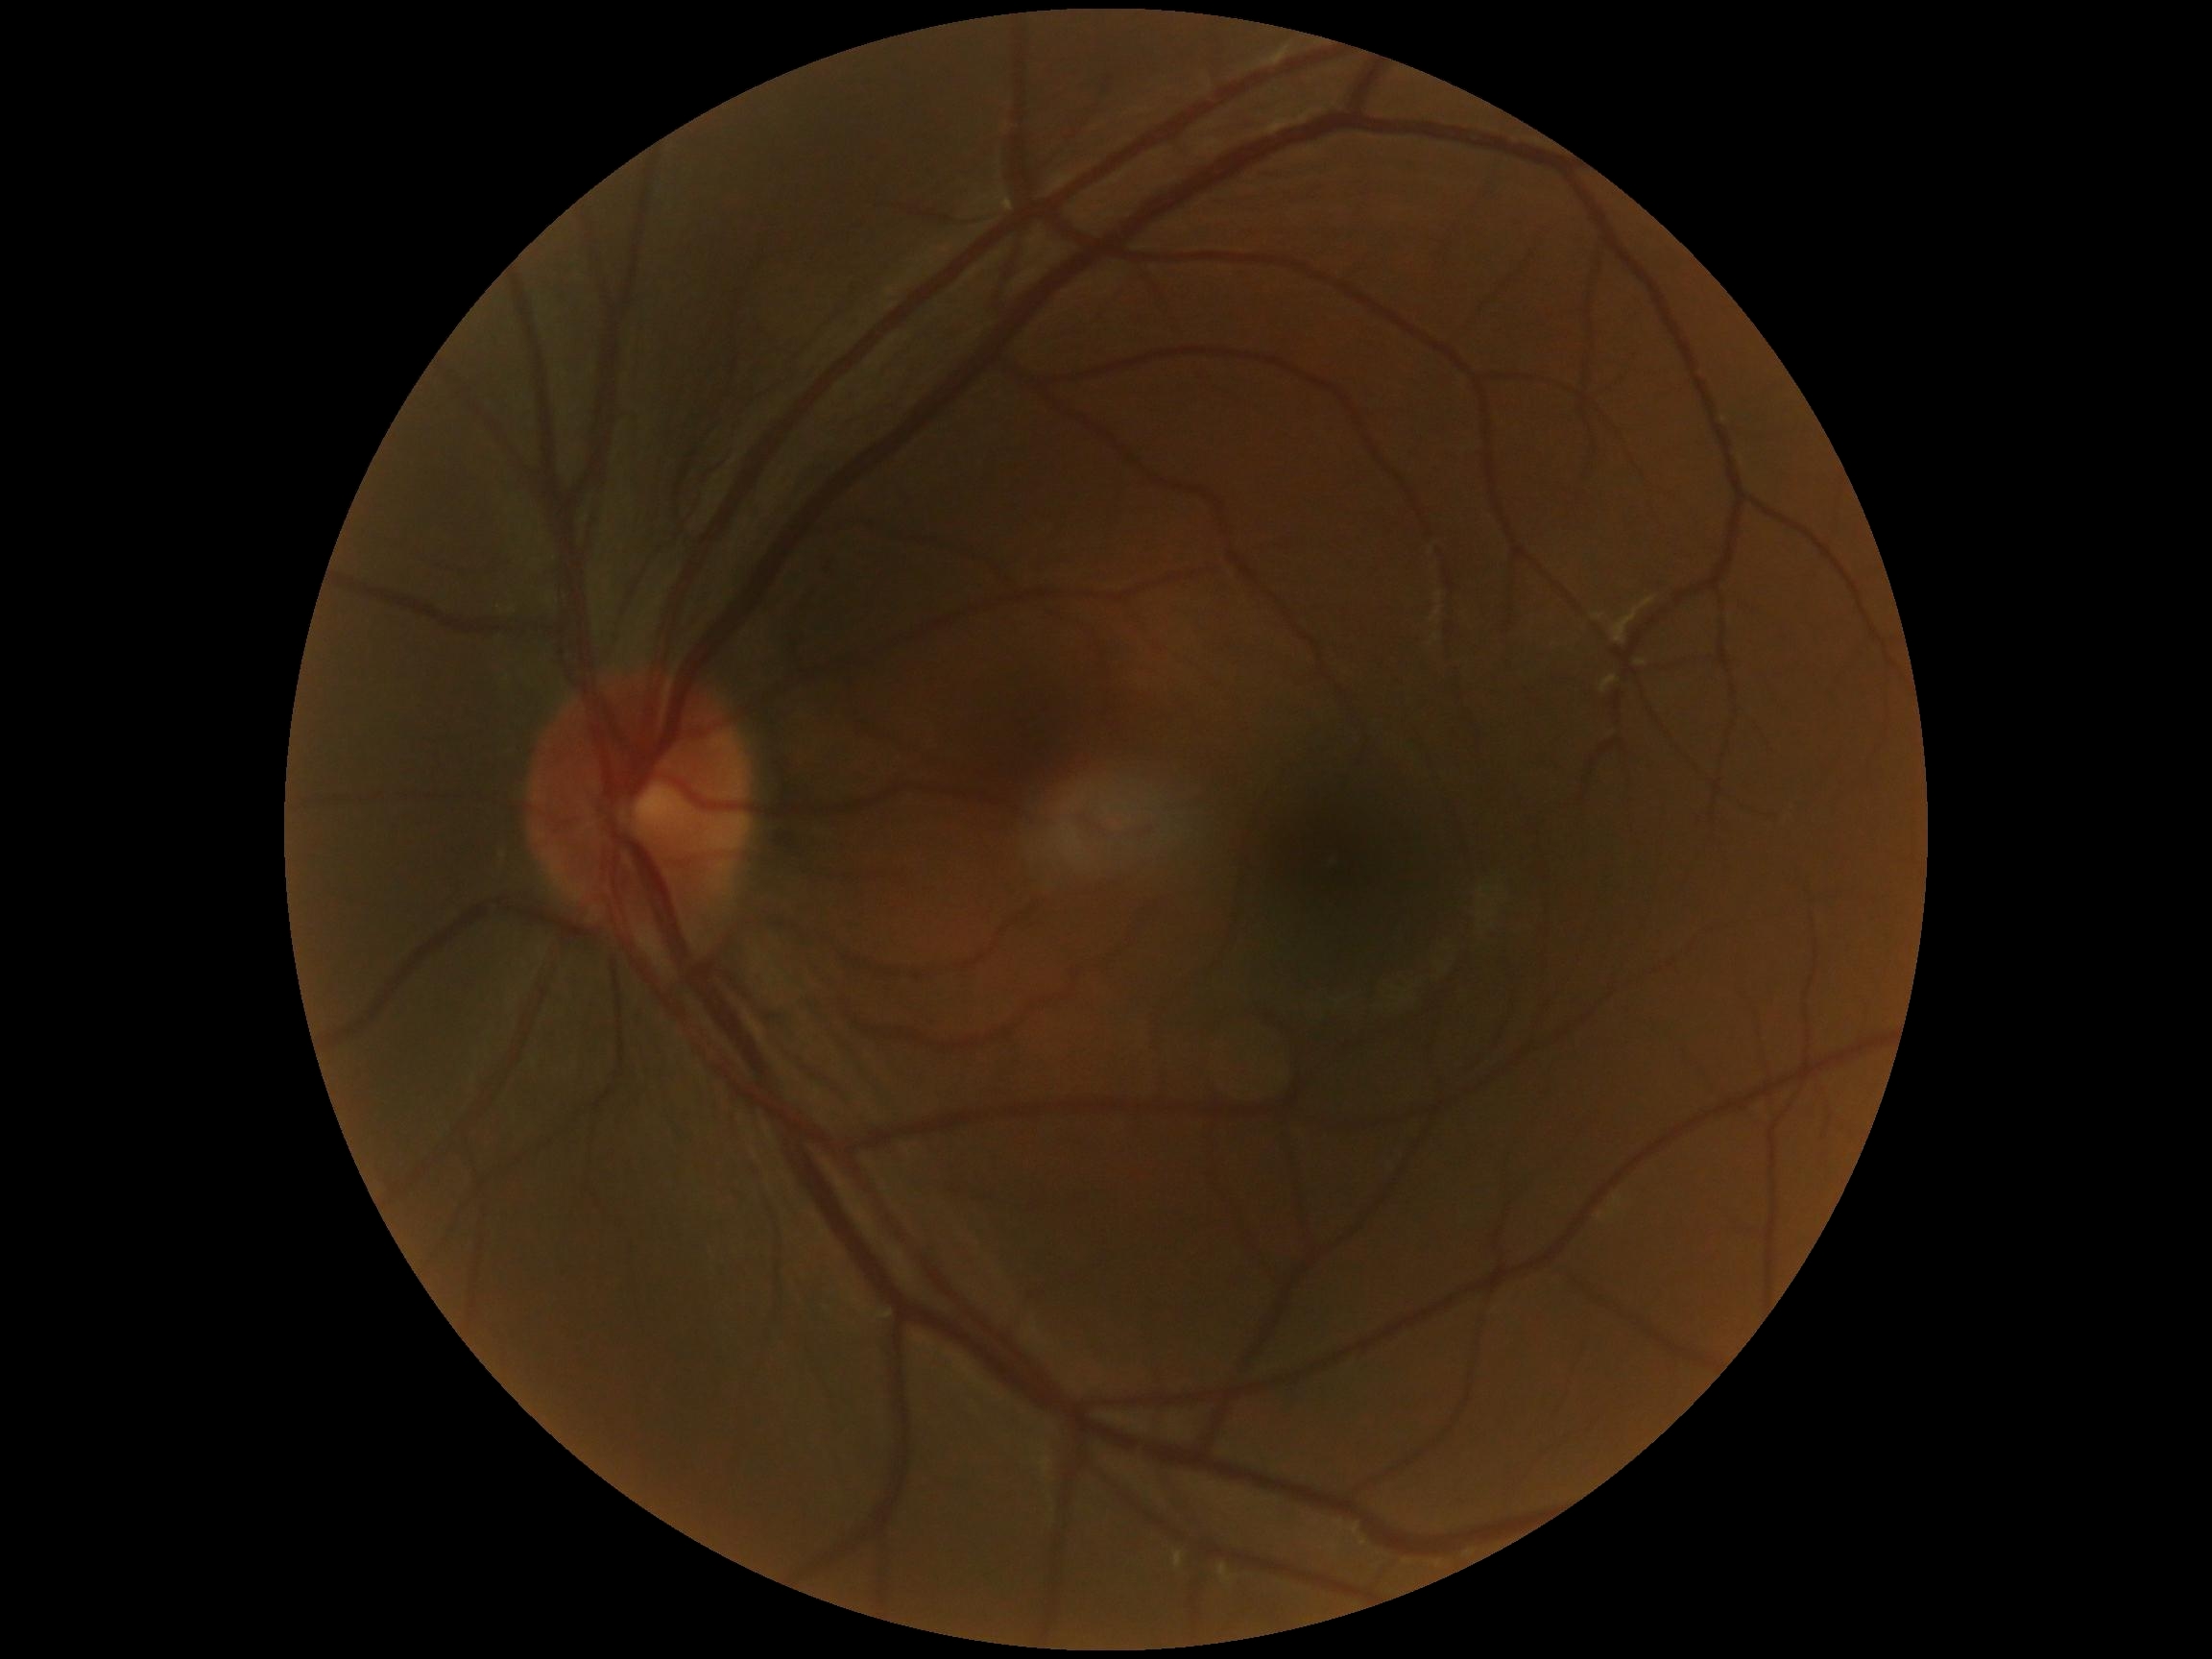   dr_impression: negative for DR
  dr_grade: grade 0 (no apparent retinopathy) — no visible signs of diabetic retinopathy